Modified Davis classification.
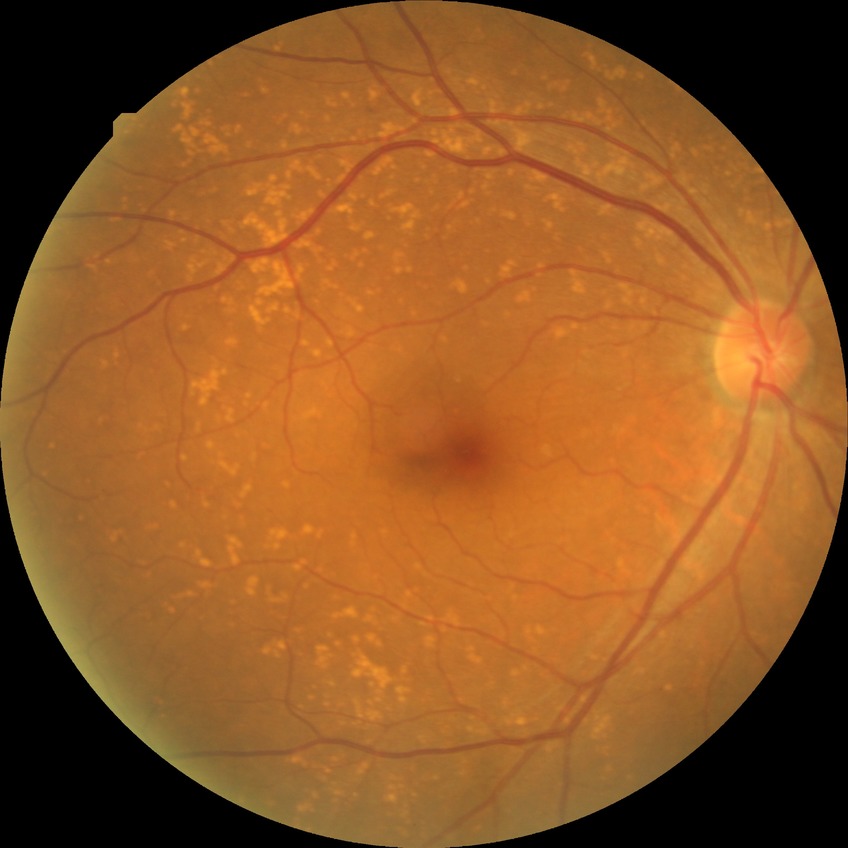

Findings:
• diabetic retinopathy severity: no diabetic retinopathy